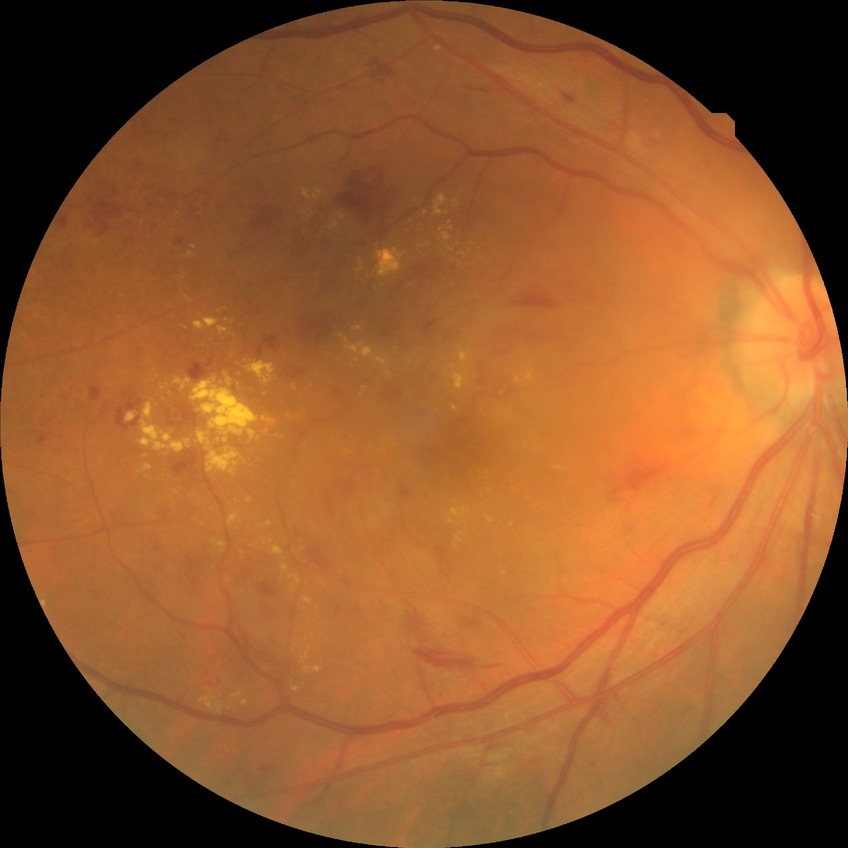 Retinopathy grade: simple diabetic retinopathy.